45 degree fundus photograph.
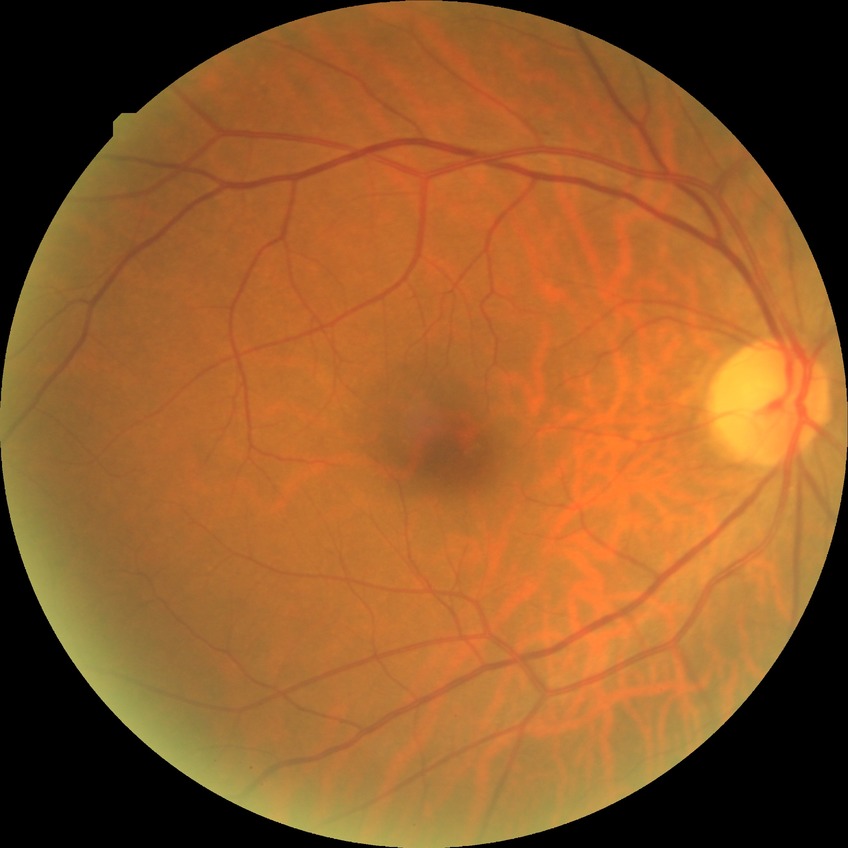

Diabetic retinopathy stage: no diabetic retinopathy.